CFP: 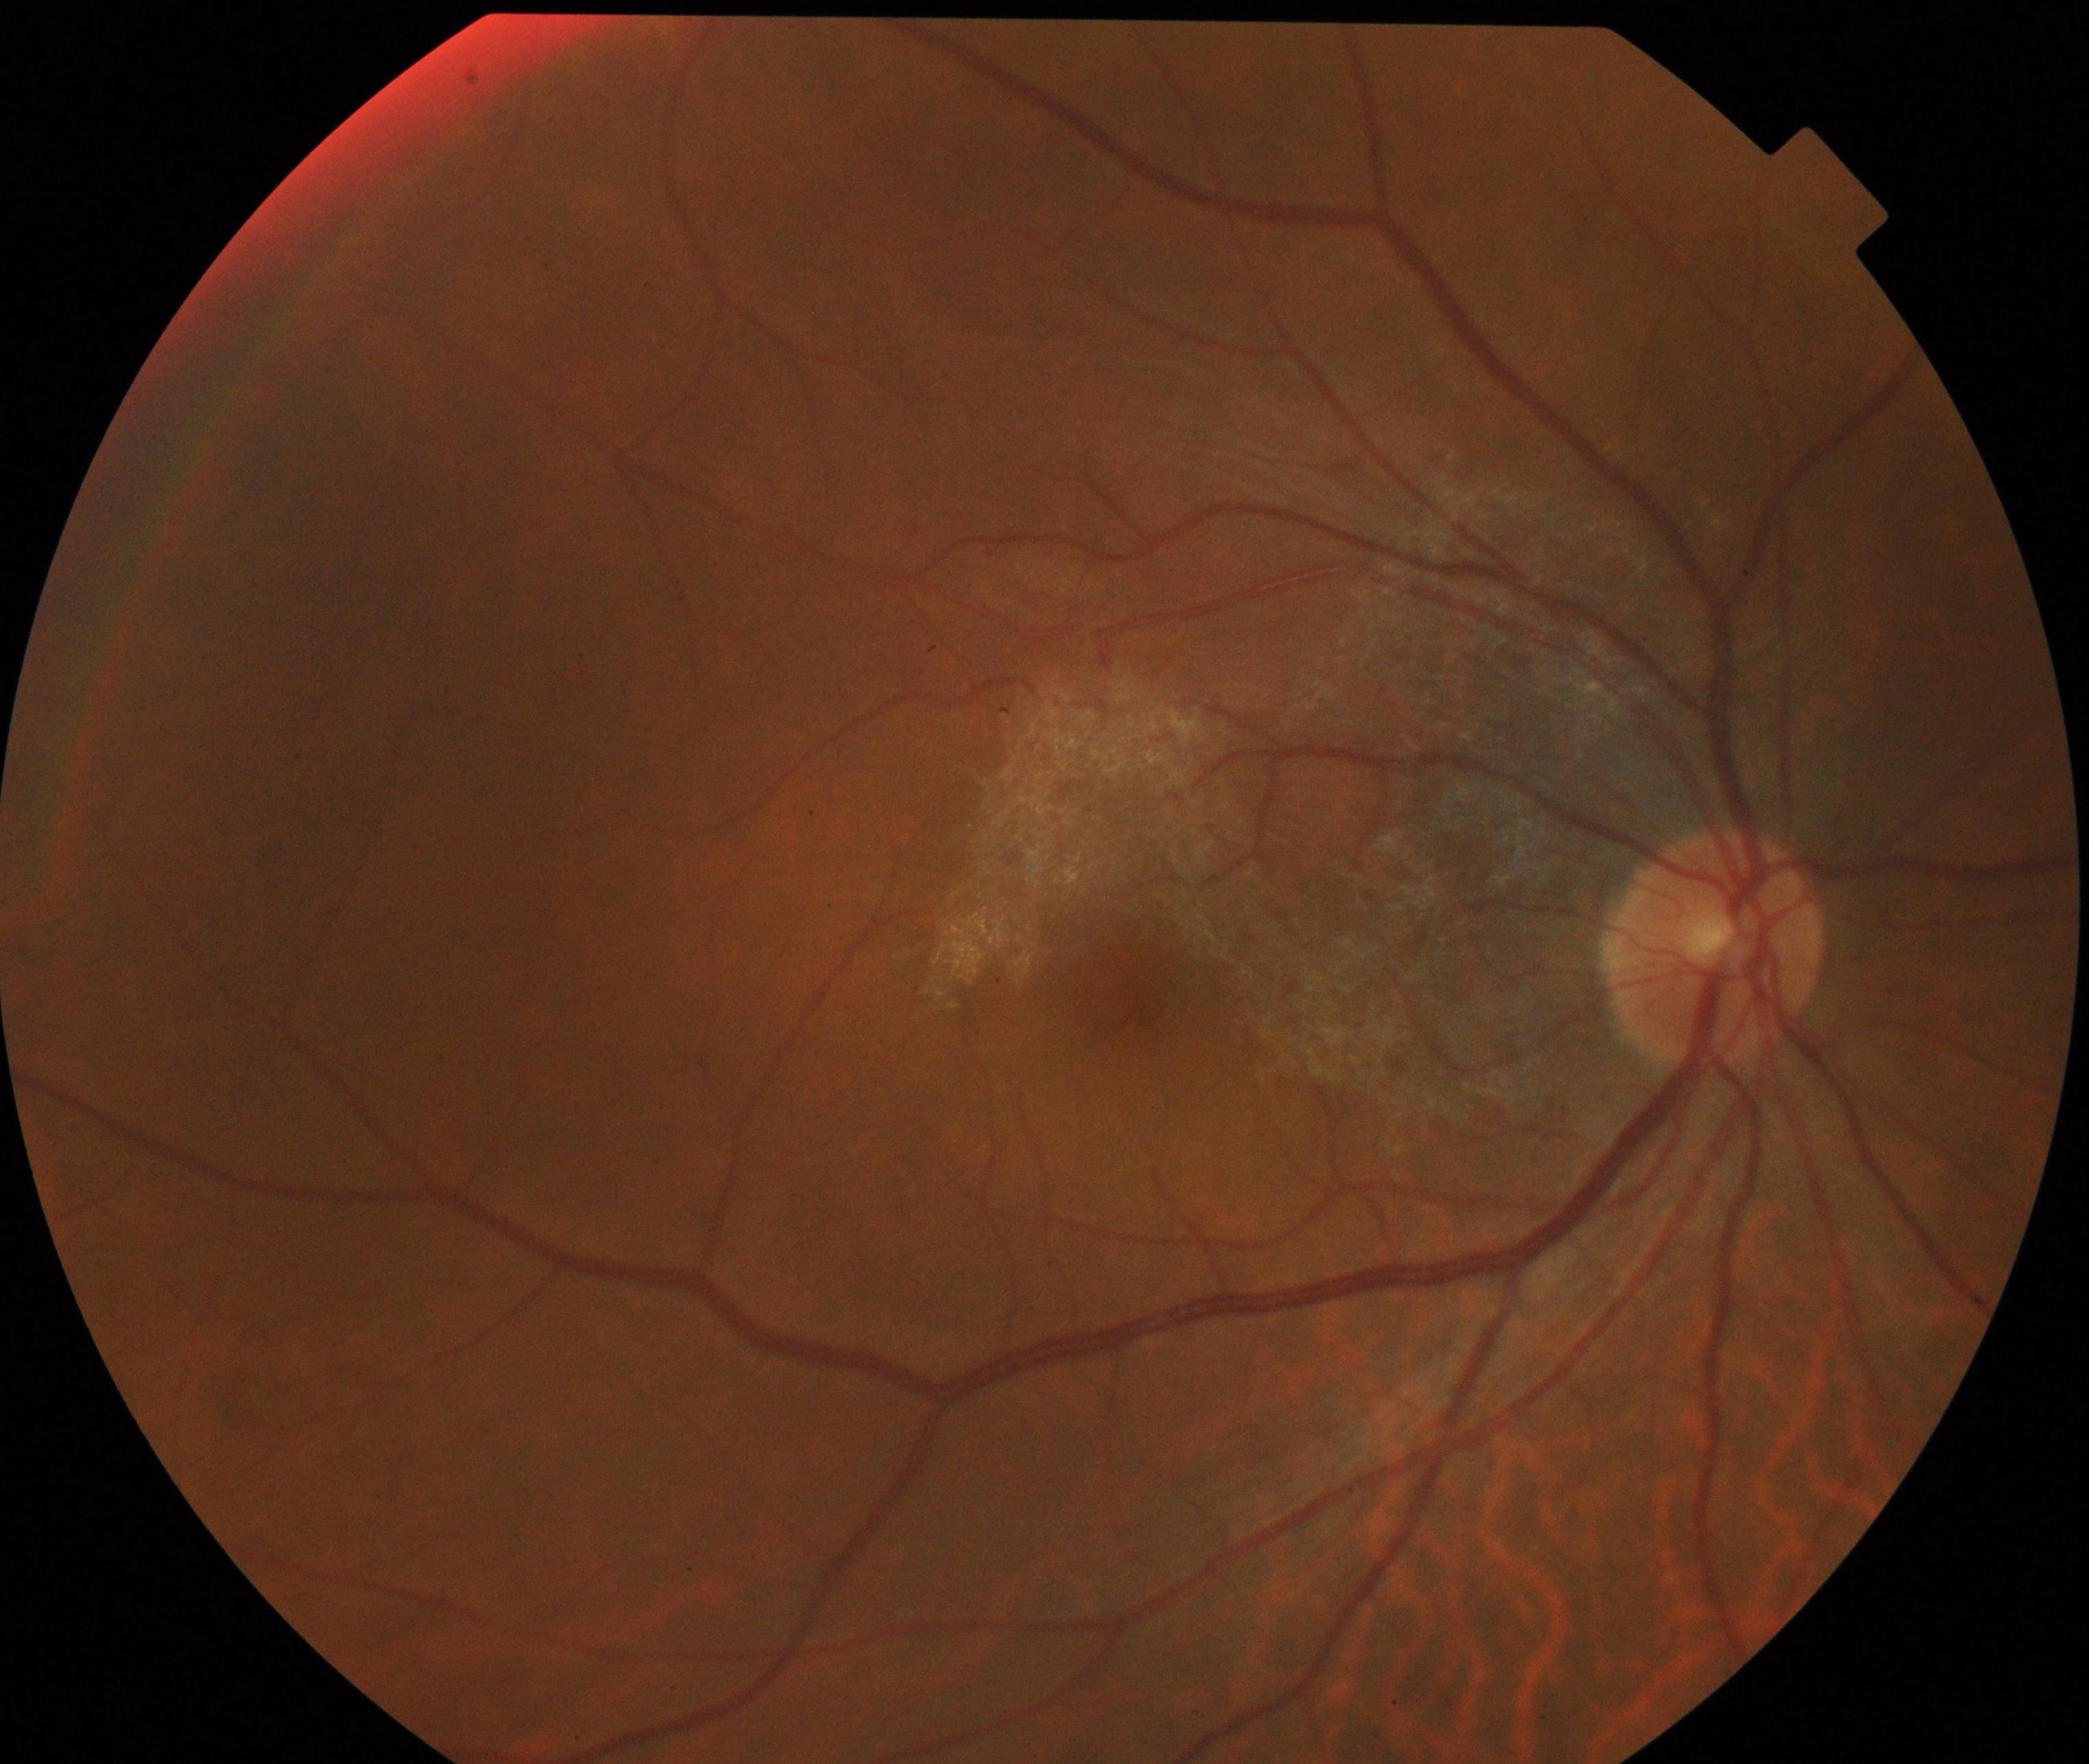
Impression: epiretinal membrane (ERM).